Image size 2352x1568, 45-degree field of view, color fundus image: 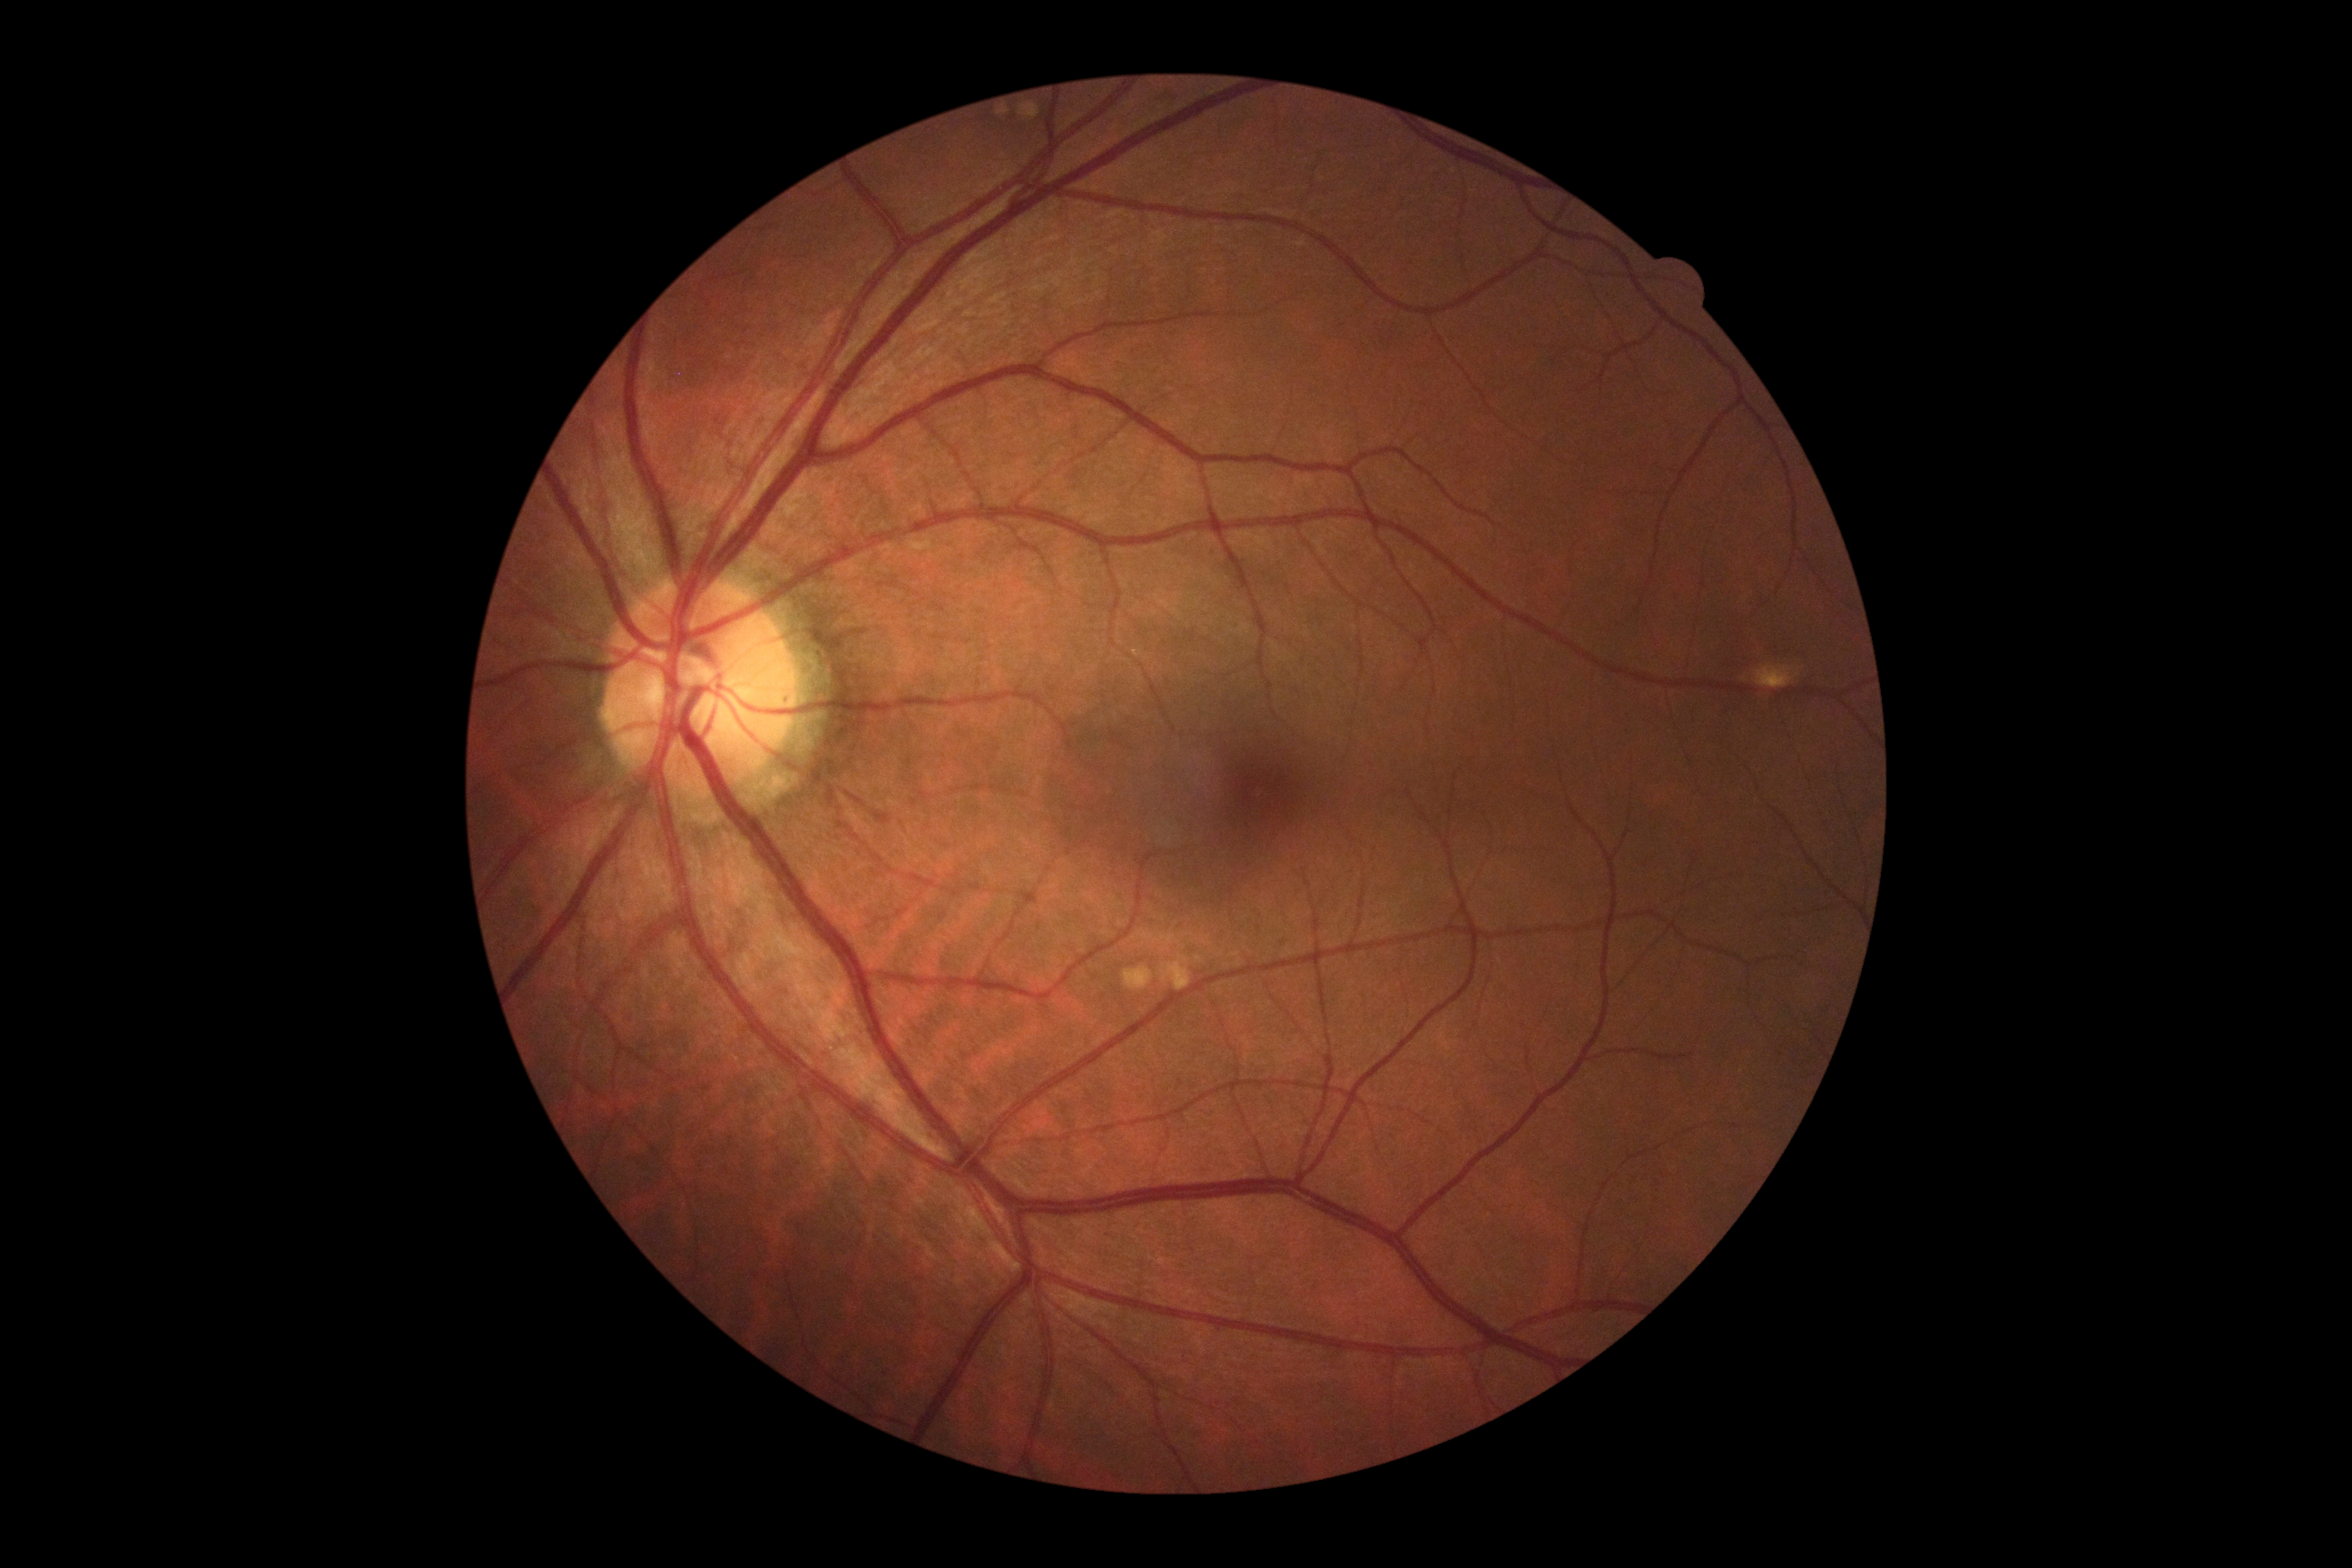 DR impression@negative for DR, retinopathy@no apparent retinopathy (grade 0).